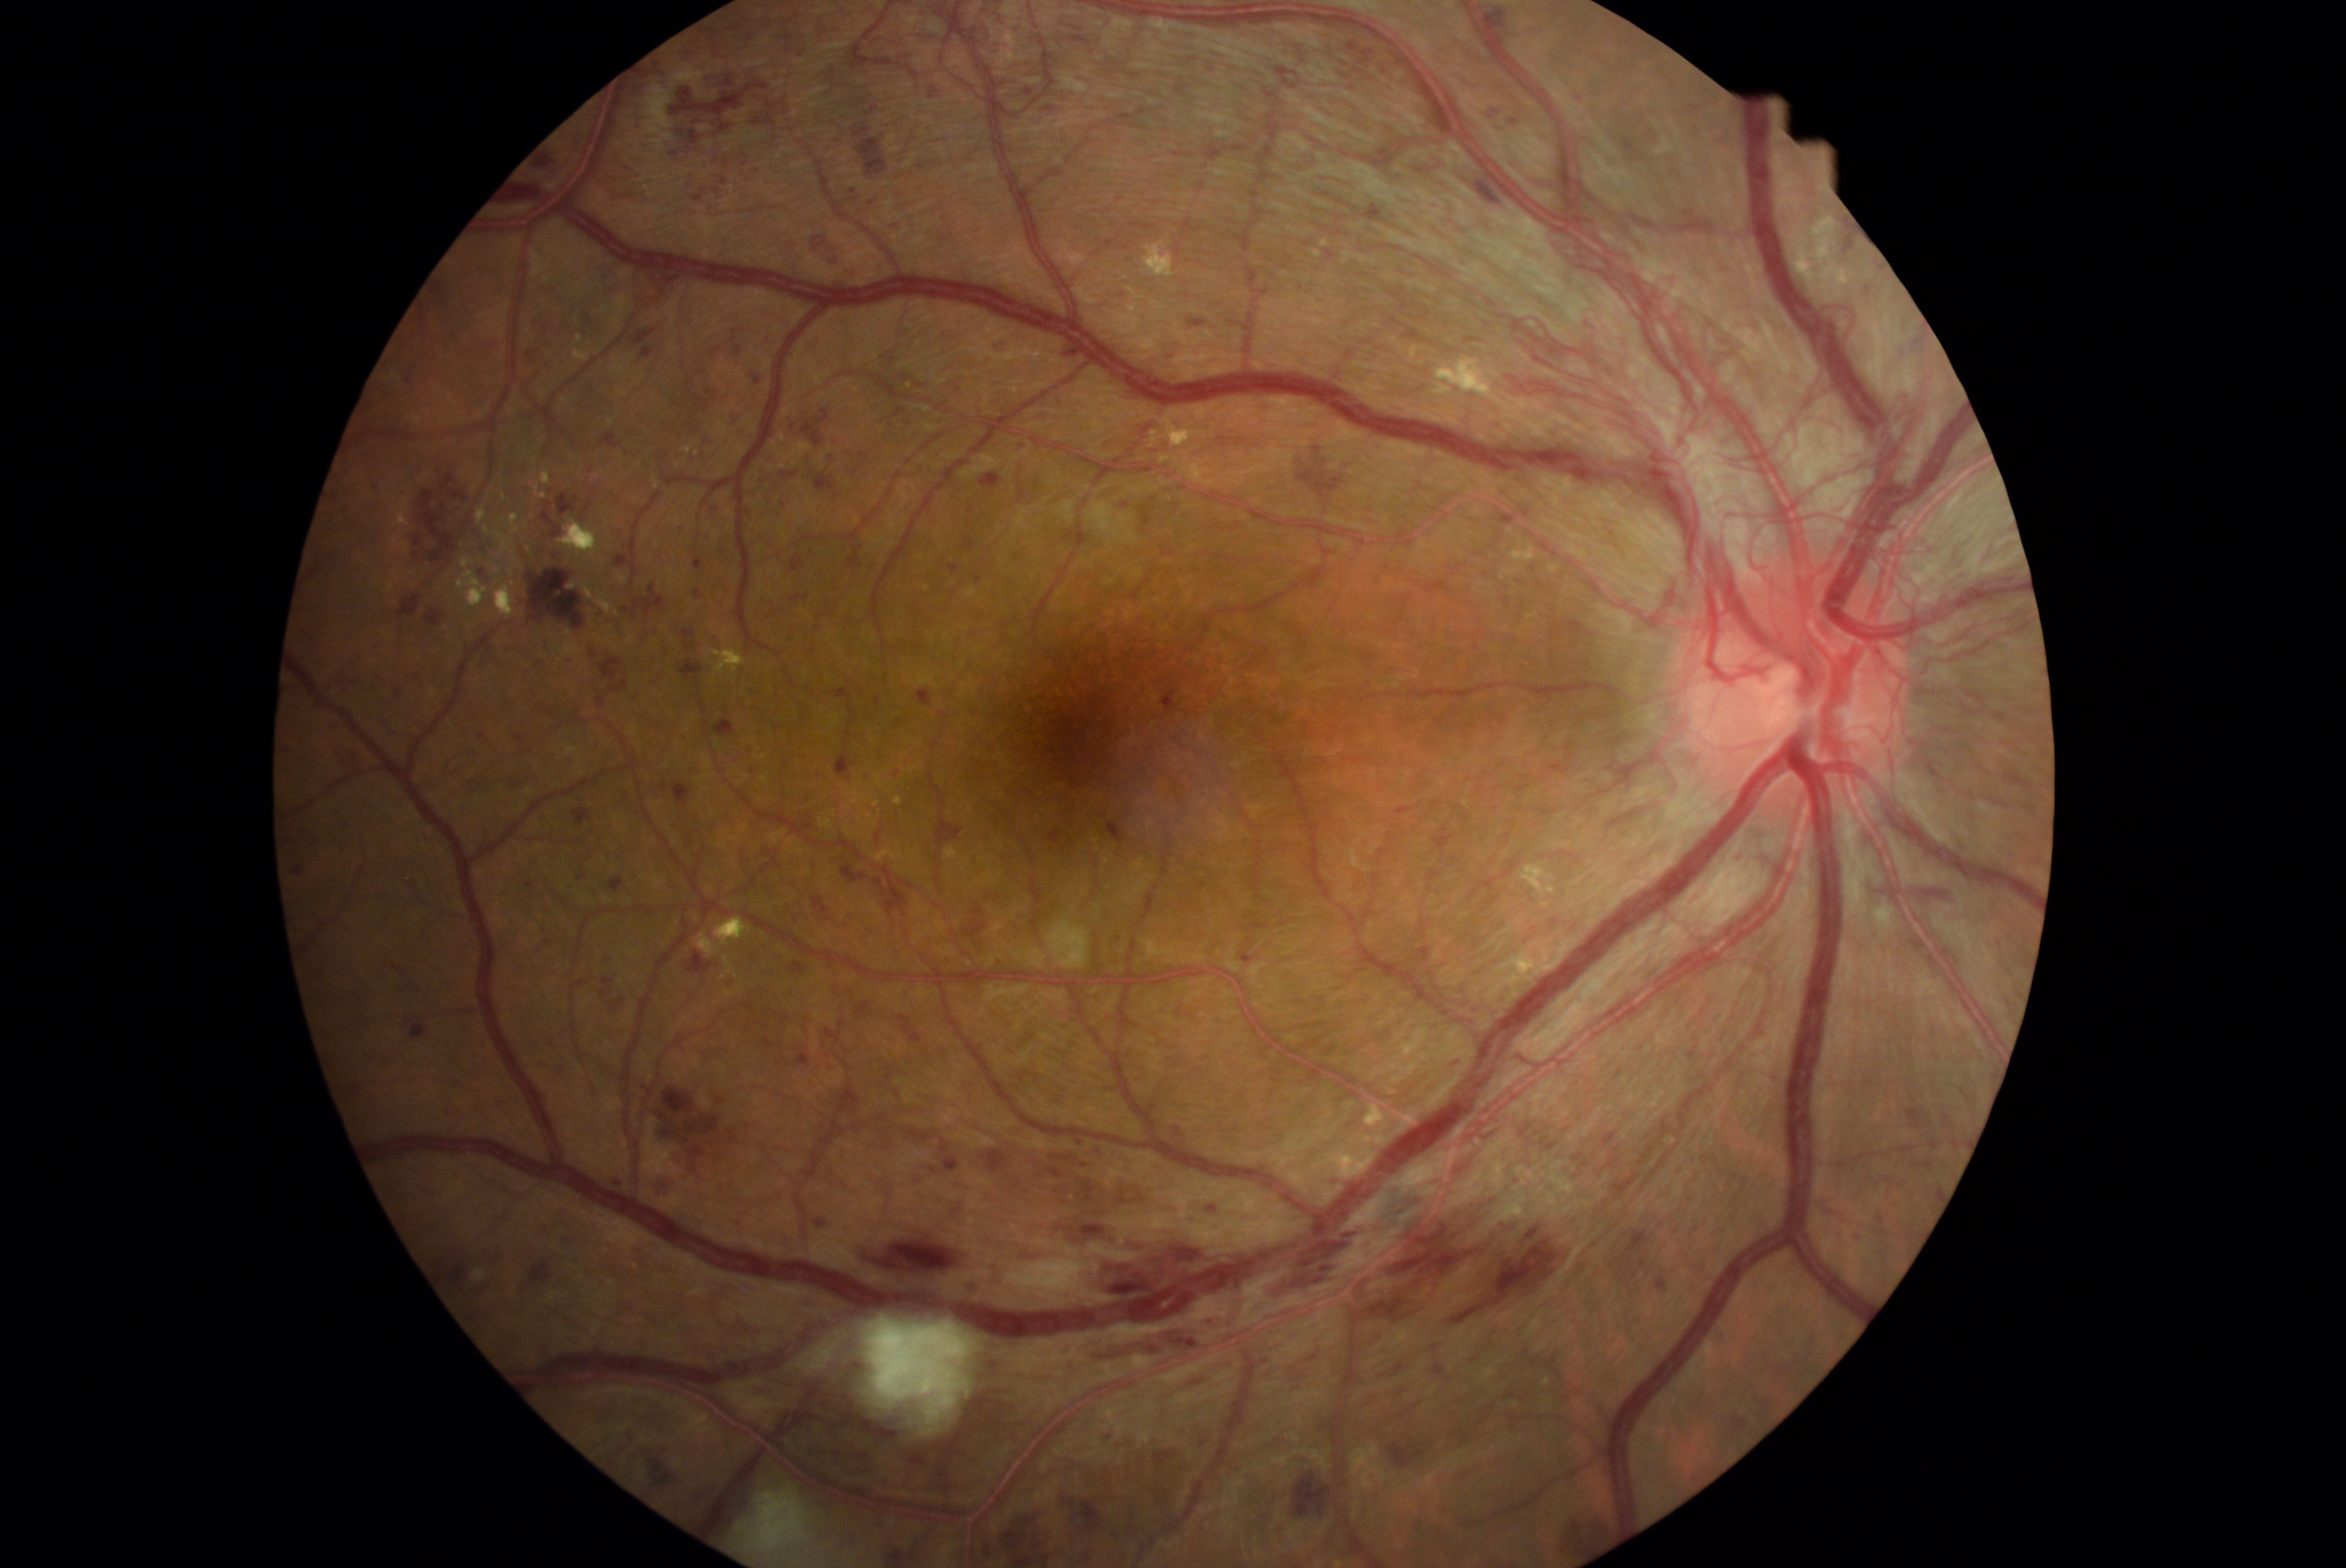

DR grade: 4/4; proliferative diabetic retinopathy.
HEs include lesions at BBox(965, 537, 976, 551); BBox(579, 311, 595, 330); BBox(634, 328, 658, 346); BBox(866, 106, 877, 115); BBox(763, 590, 801, 626); BBox(1269, 1224, 1364, 1298); BBox(870, 1243, 957, 1274); BBox(1906, 1050, 1914, 1061); BBox(837, 731, 857, 780); BBox(1967, 1098, 1977, 1103); BBox(476, 727, 492, 742); BBox(1914, 1160, 1934, 1169); BBox(576, 840, 586, 846); BBox(706, 503, 721, 518); BBox(763, 1037, 774, 1048); BBox(598, 655, 623, 680); BBox(426, 609, 445, 626); BBox(813, 896, 833, 921).
Small HEs approximately at (889; 1078); (1934; 1033).